CFP, 1924 by 1556 pixels, FOV: 50 degrees:
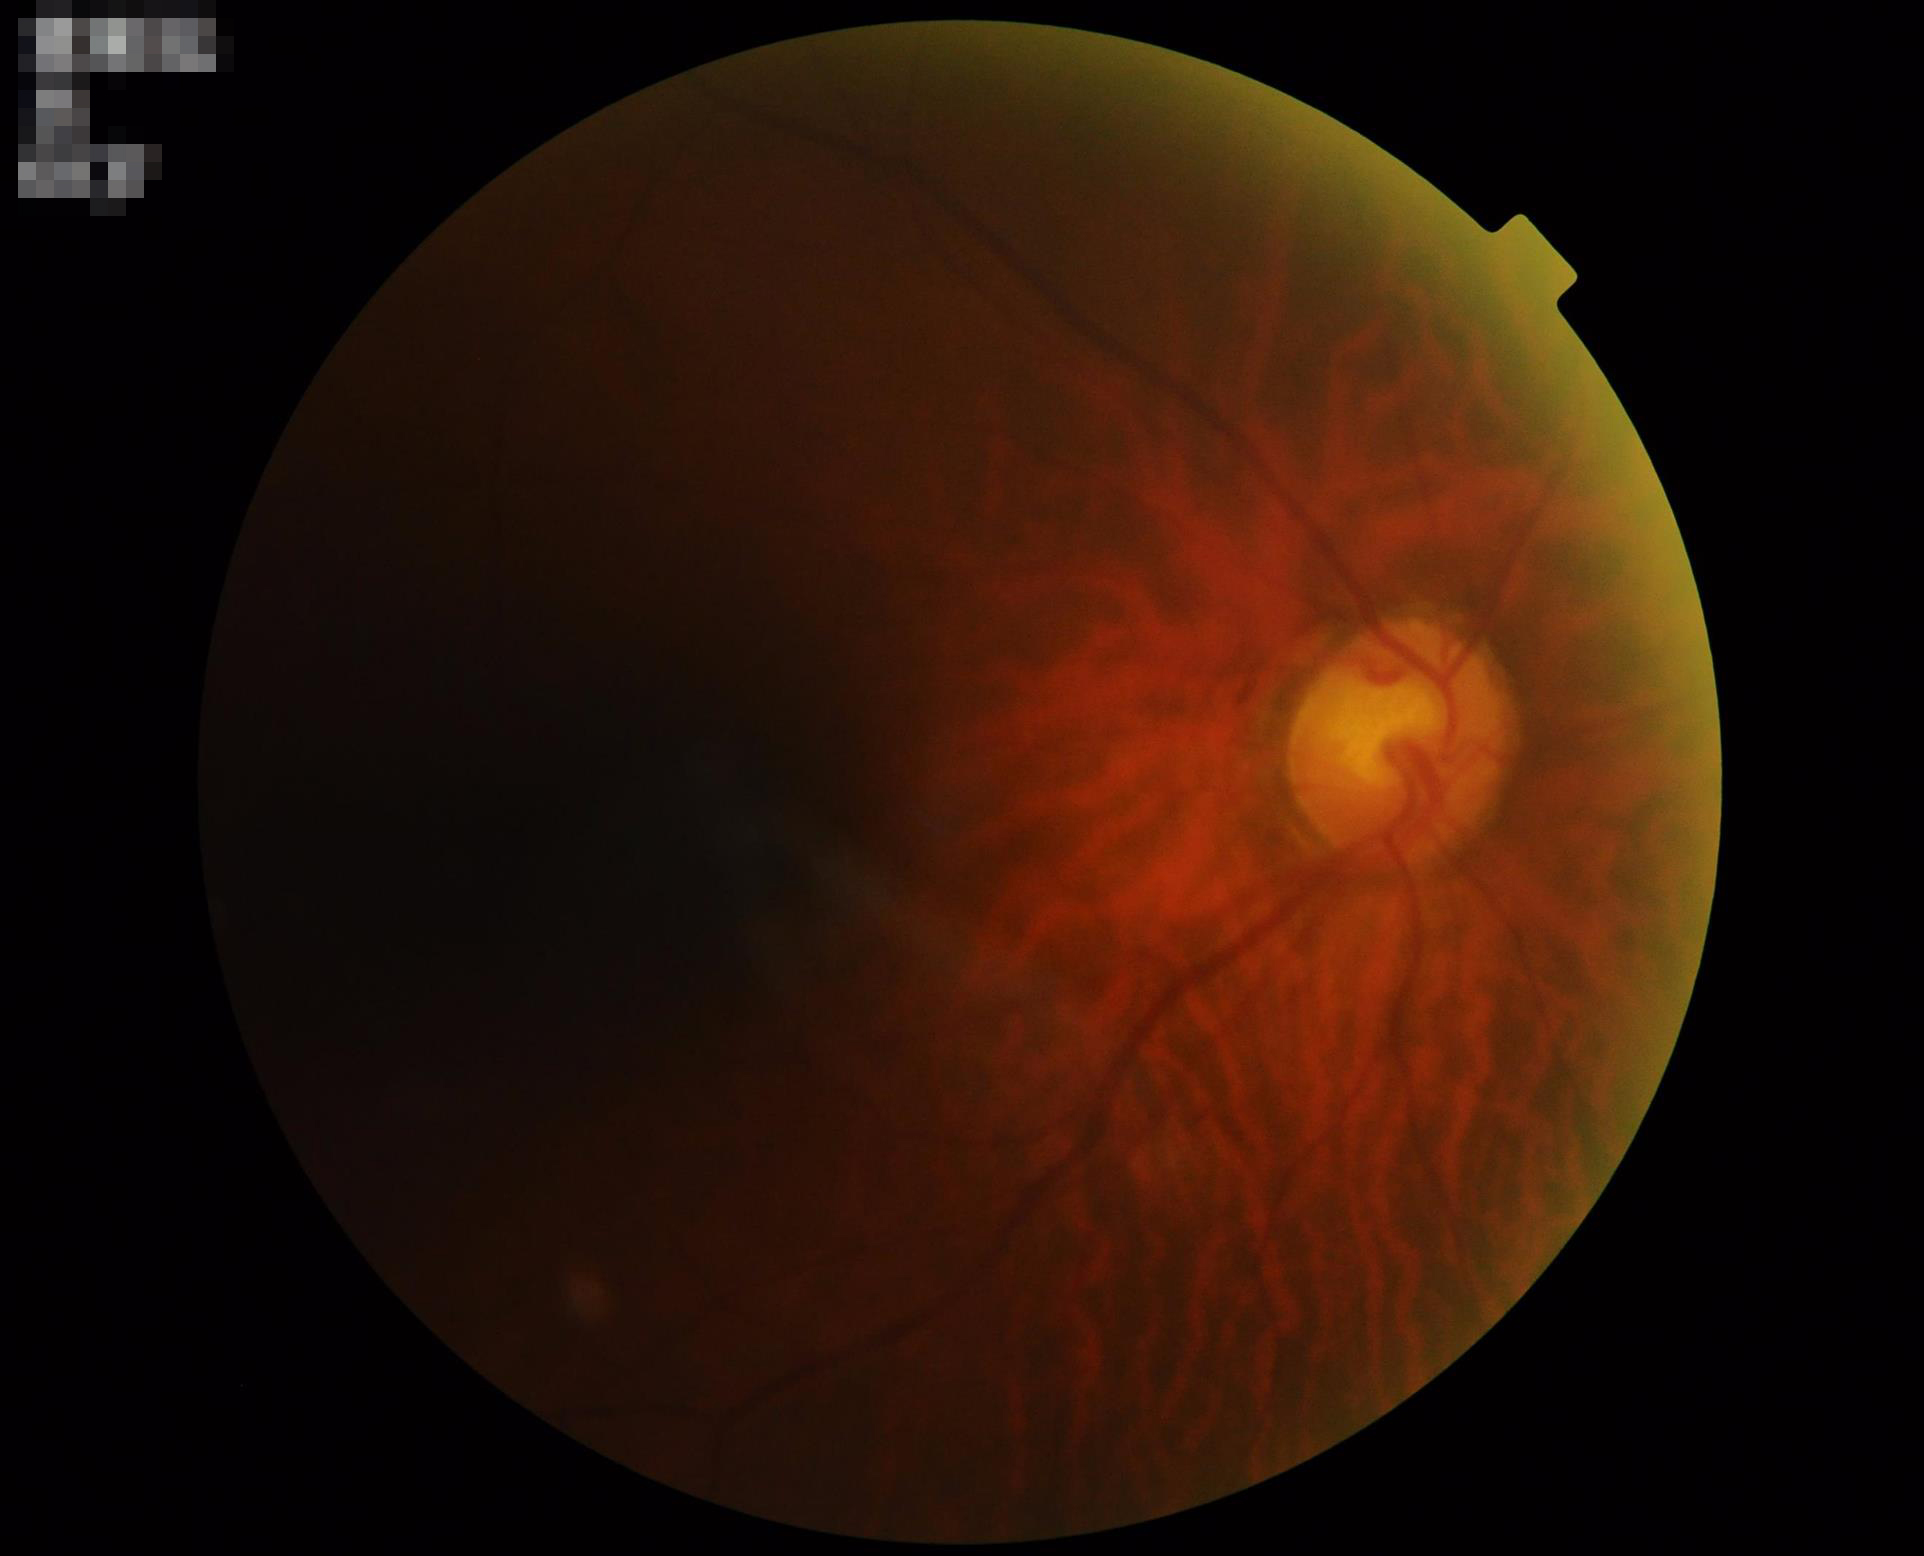

Image quality: sharpness: poor | illumination: poor | overall: inadequate | contrast: good.